FOV: 45 degrees; color fundus photograph.
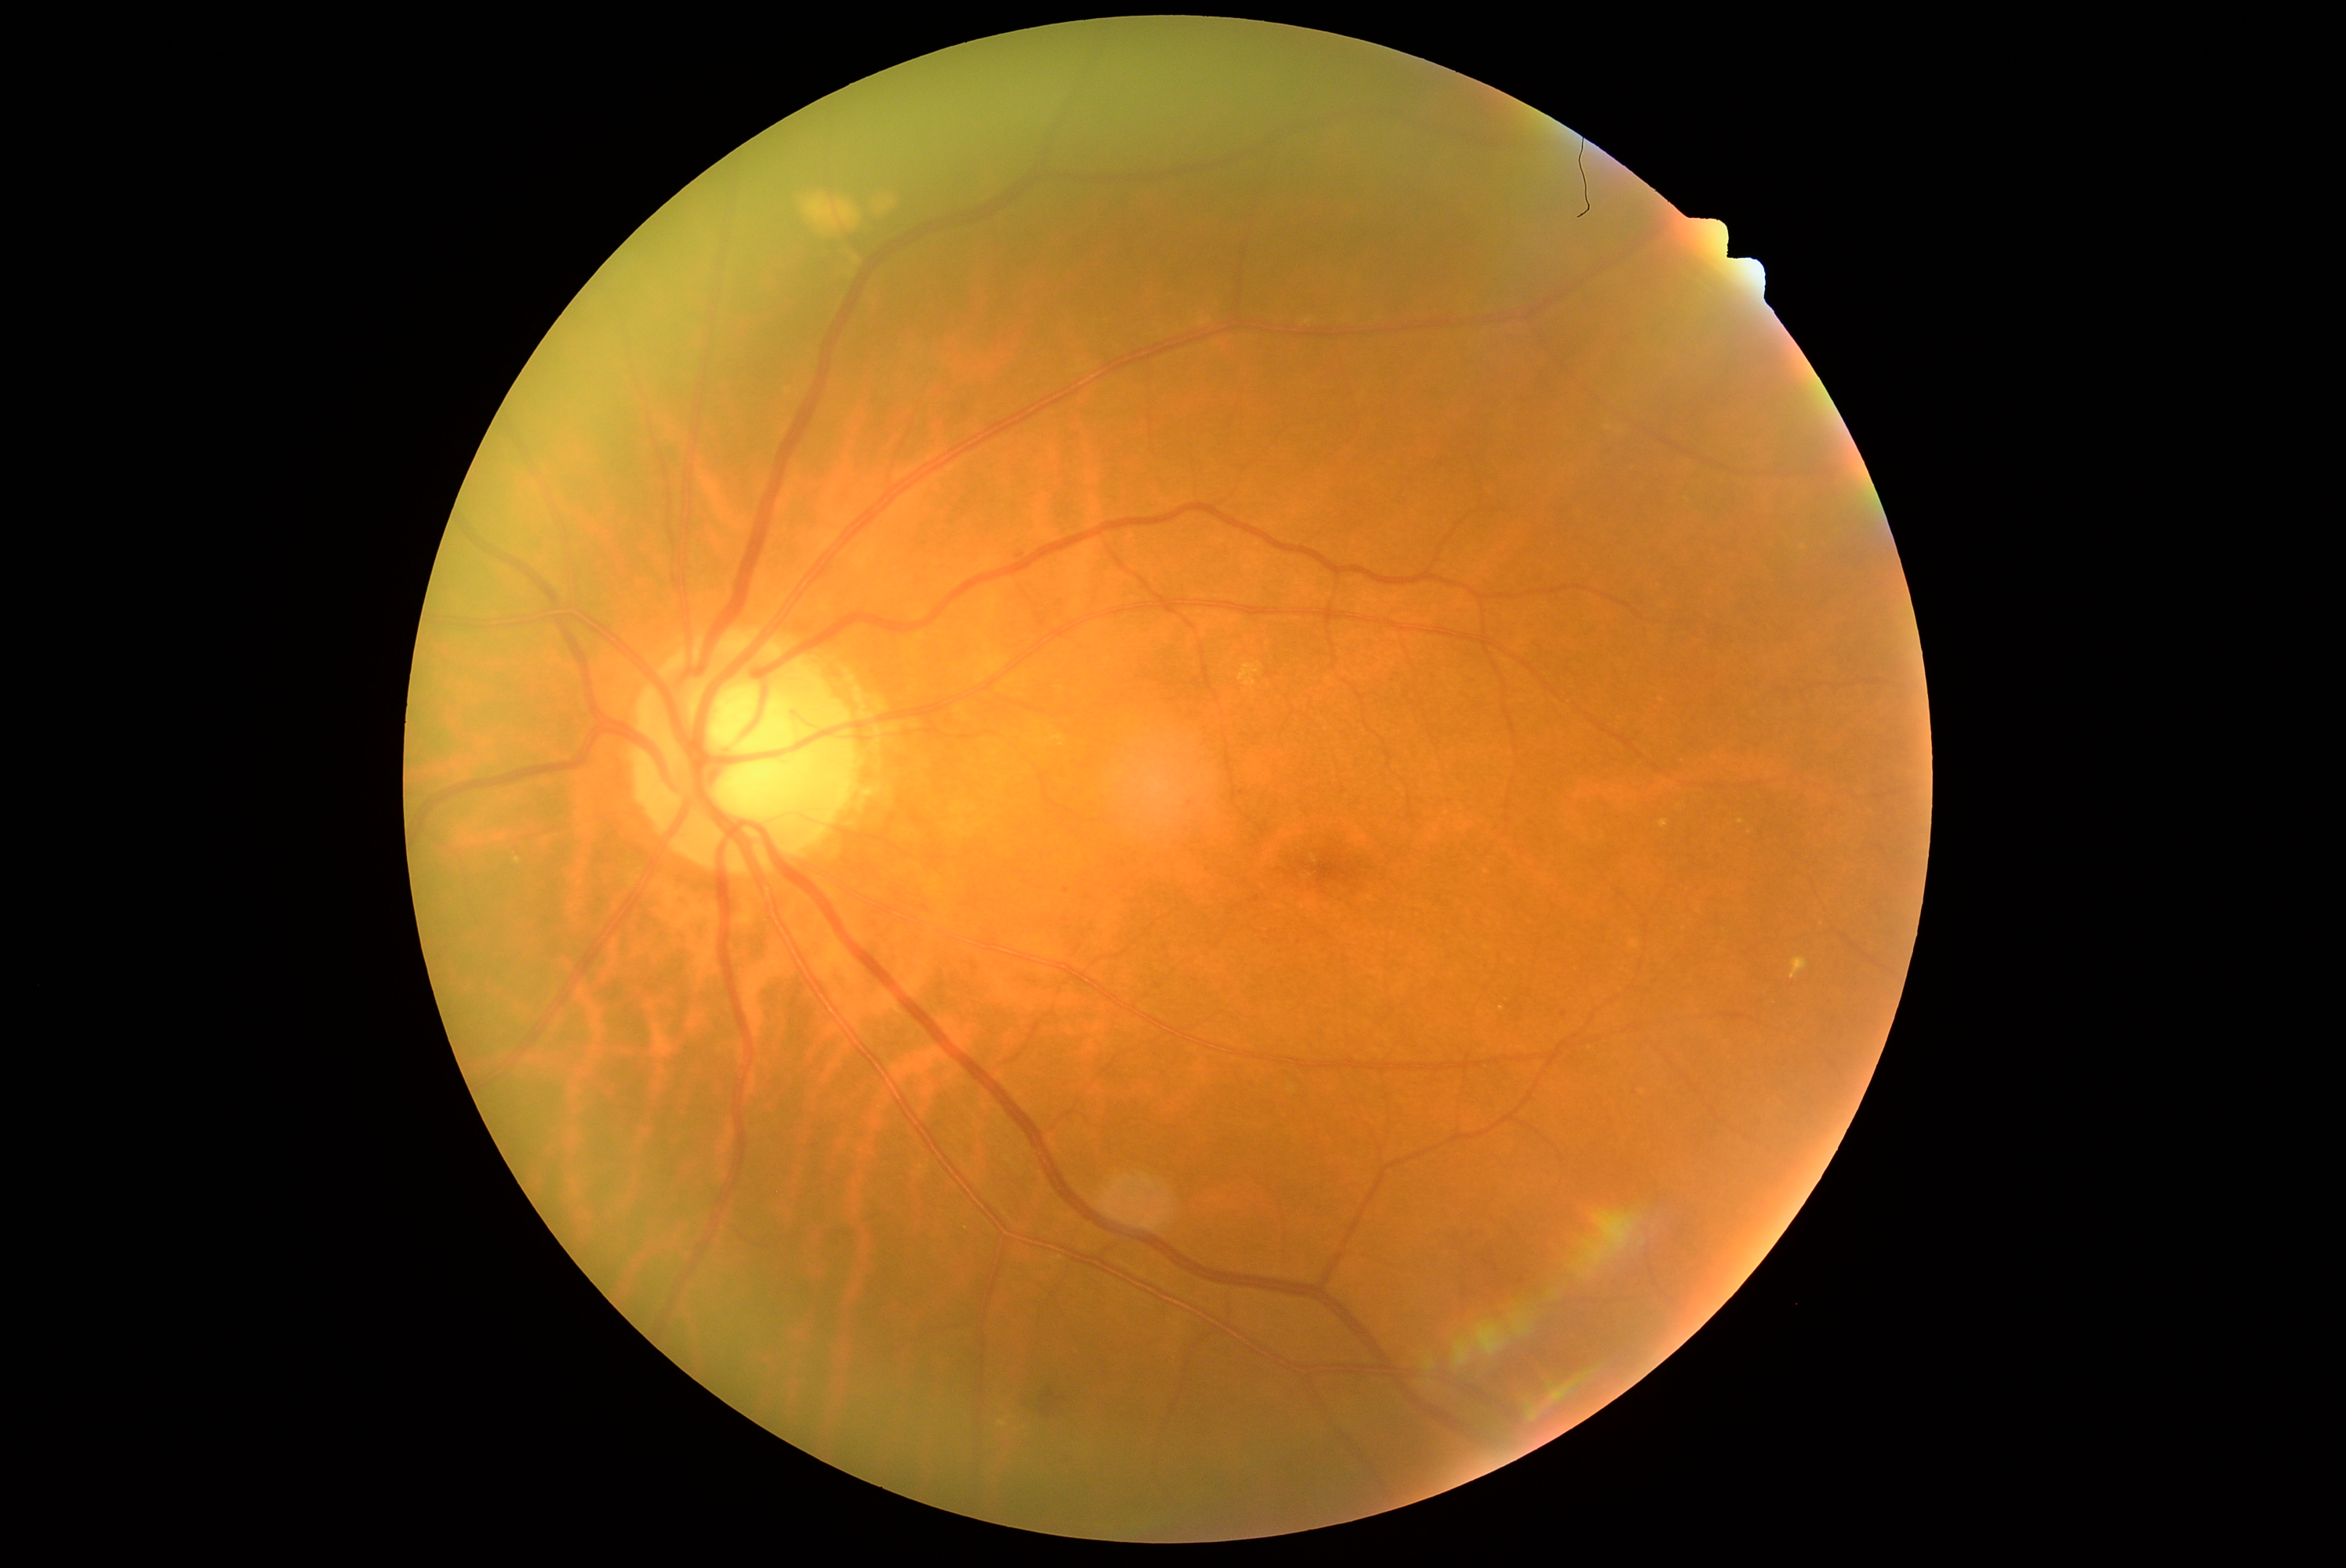 DR = 2/4